Acquired with a NIDEK AFC-230 · no pharmacologic dilation: 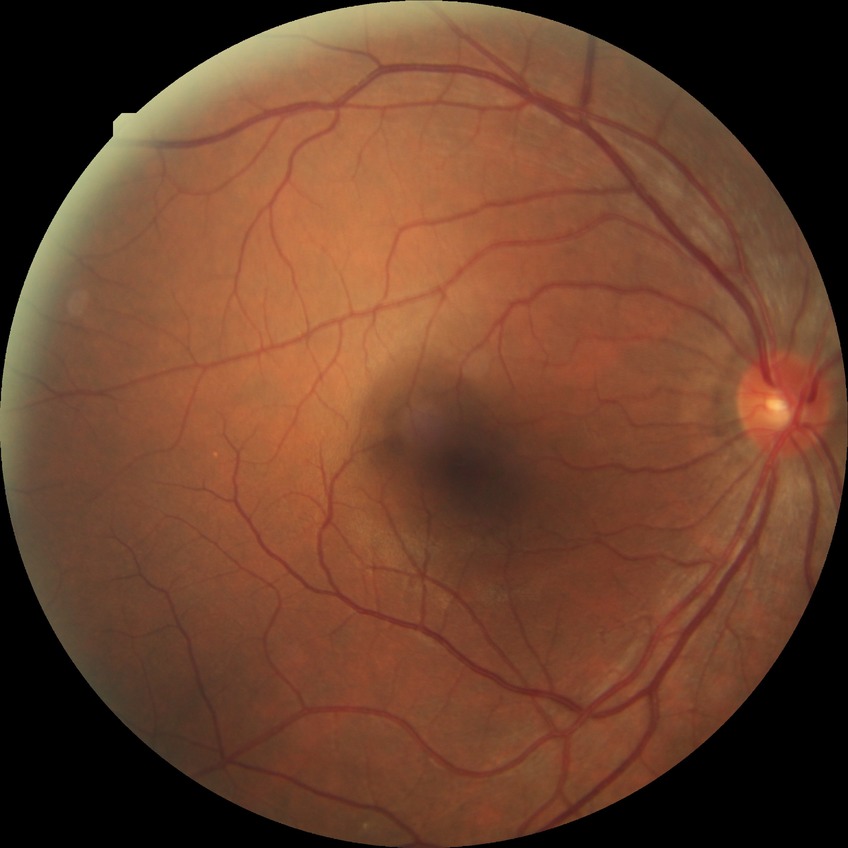 {"davis_grade": "no diabetic retinopathy (NDR)"}